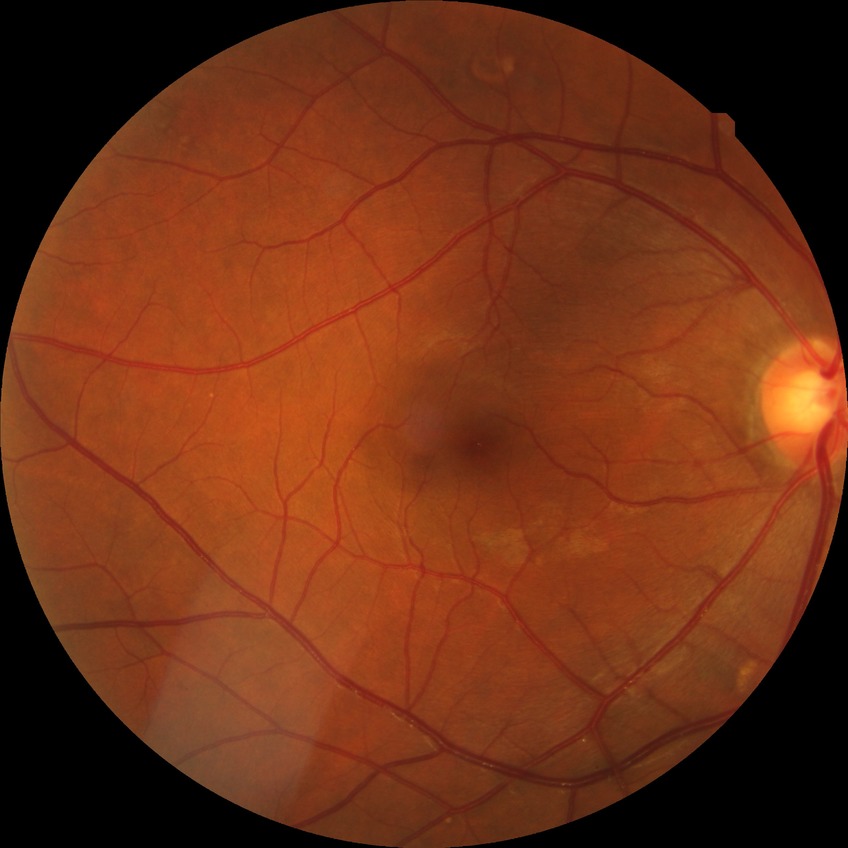
Retinopathy stage is no diabetic retinopathy.